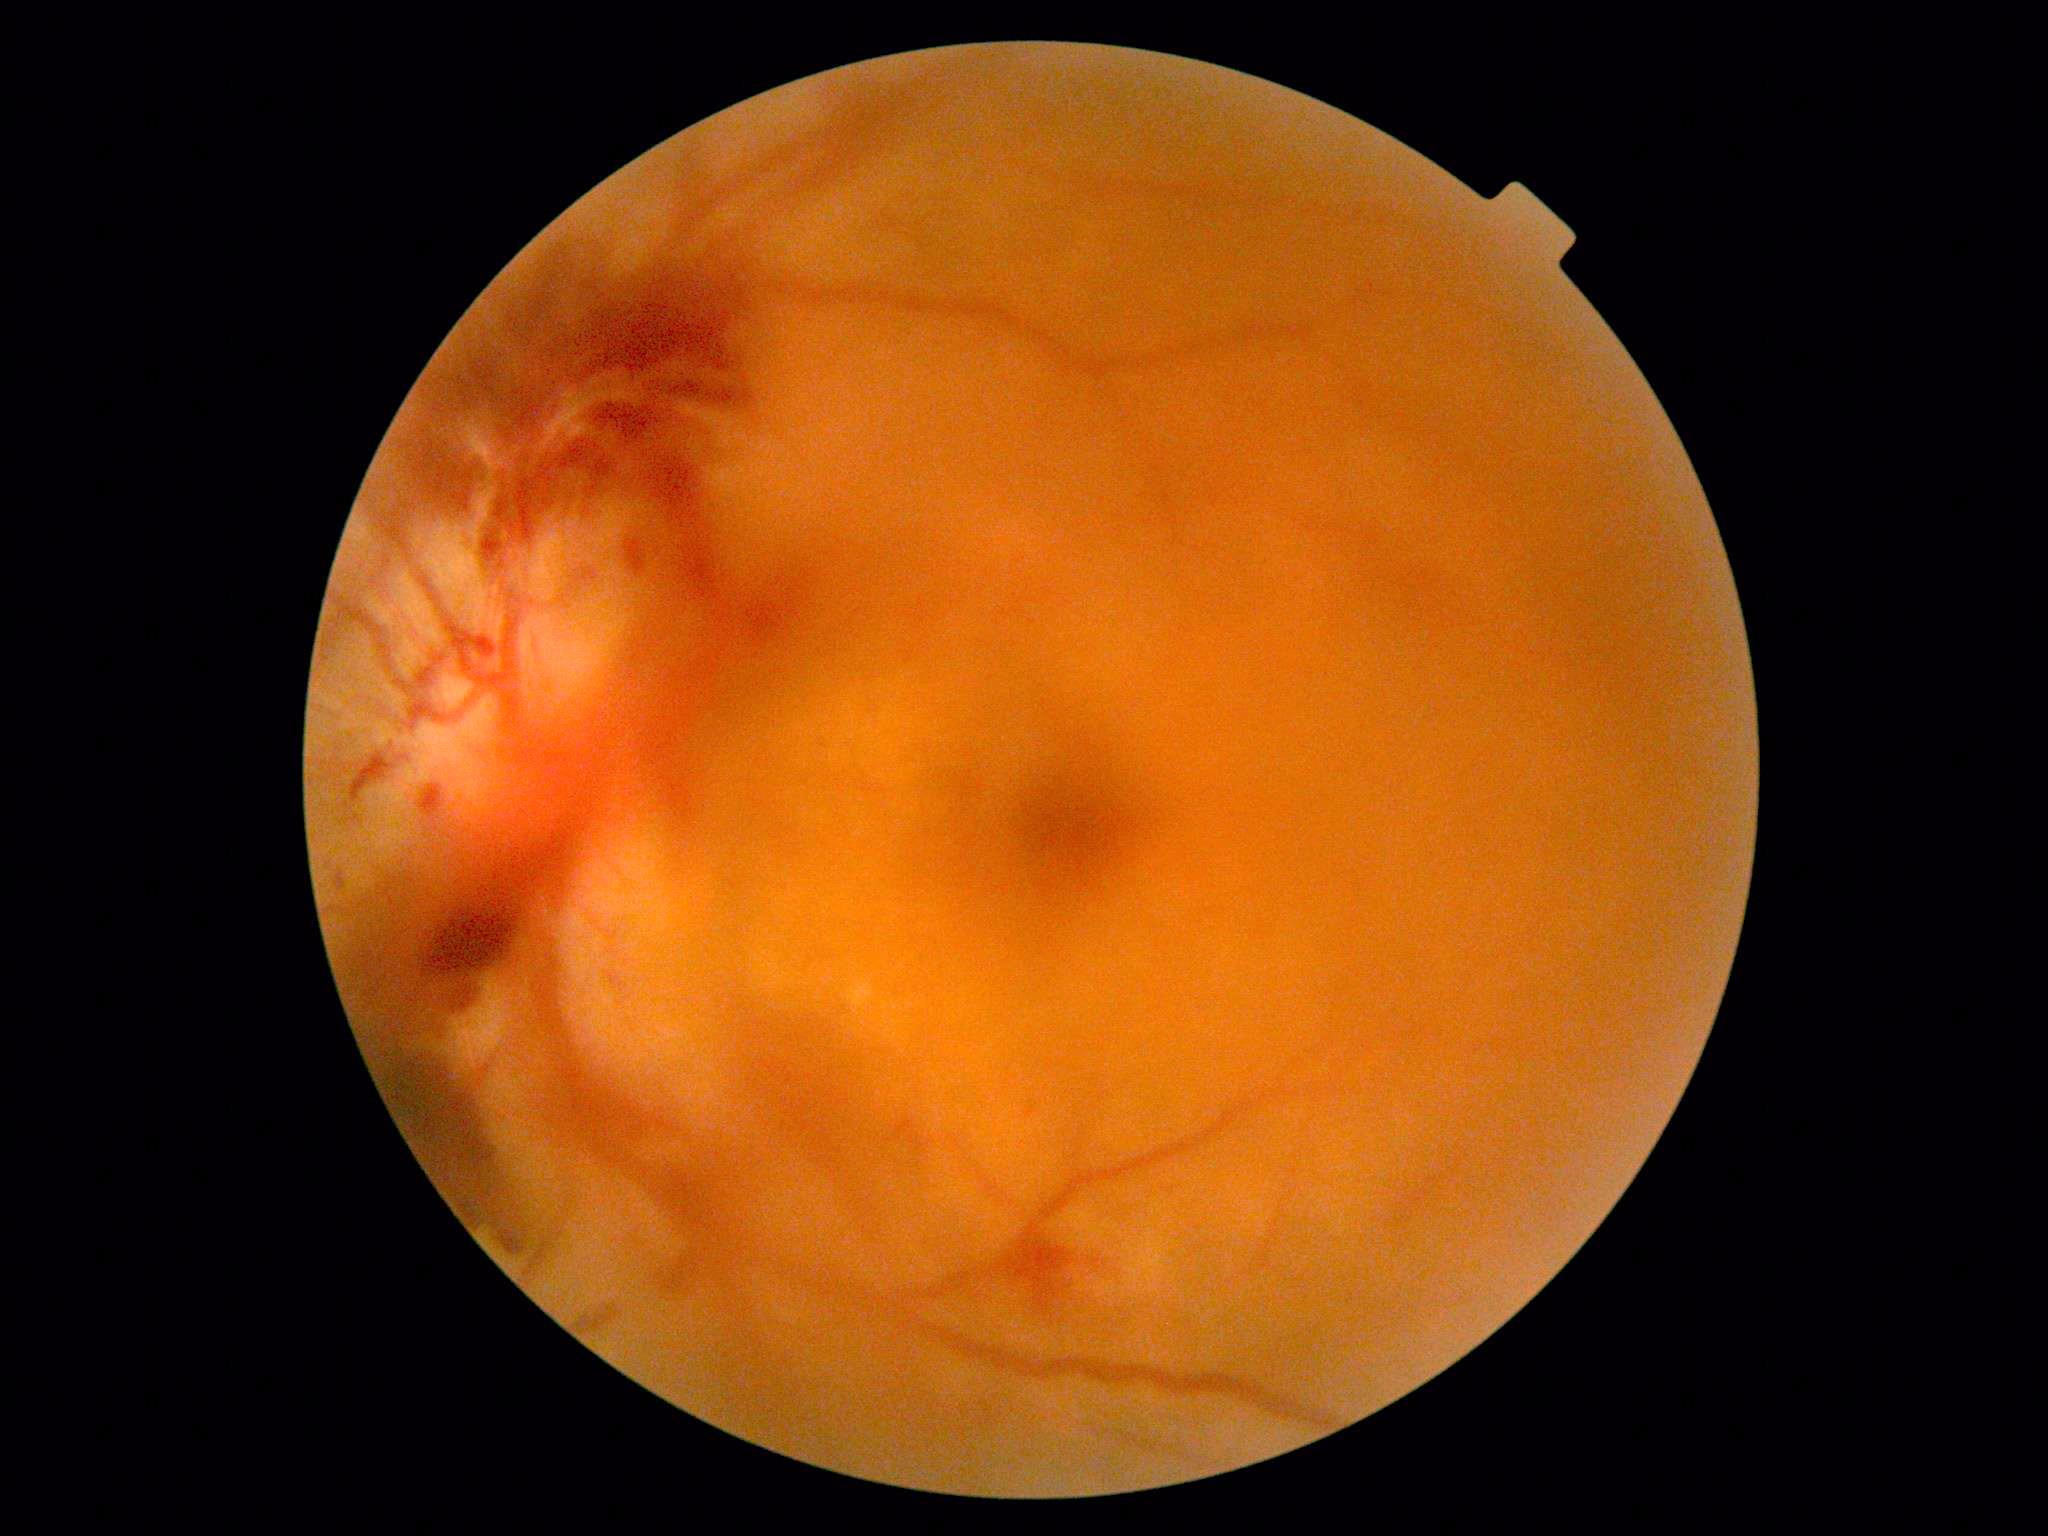
{
  "dr_grade": "grade 4"
}